2212x1659: 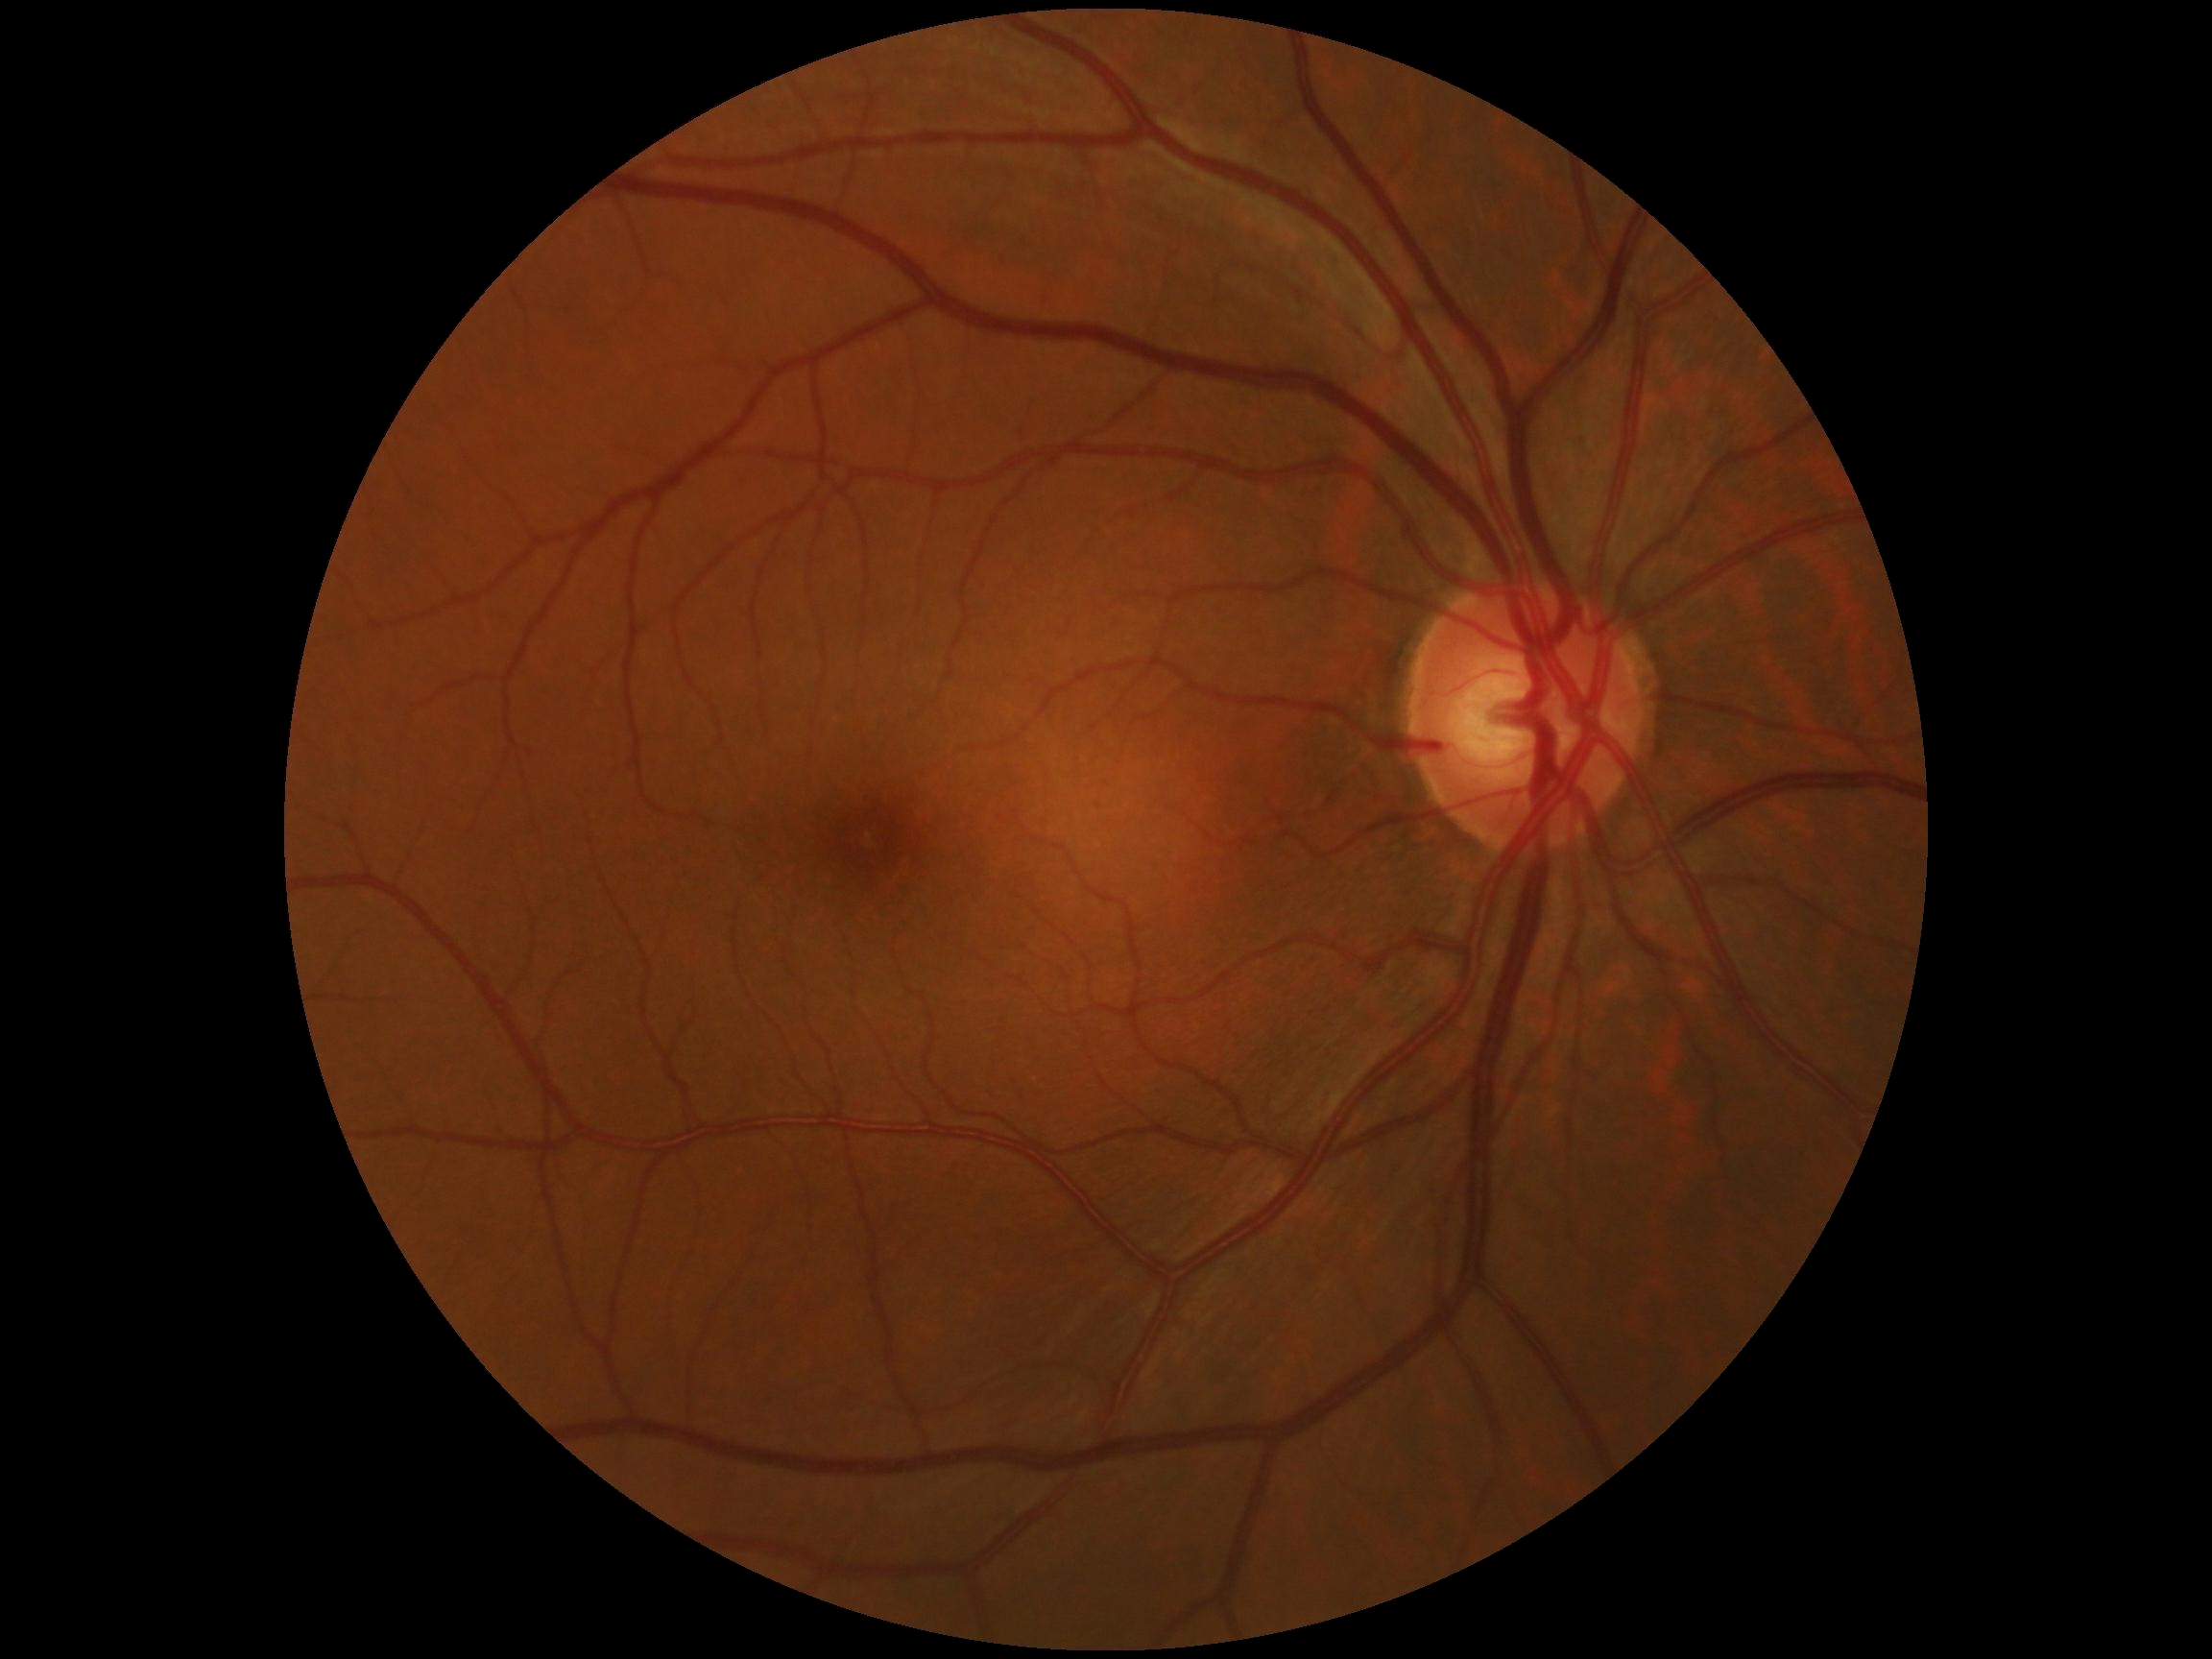

{"dr_grade": "0"}